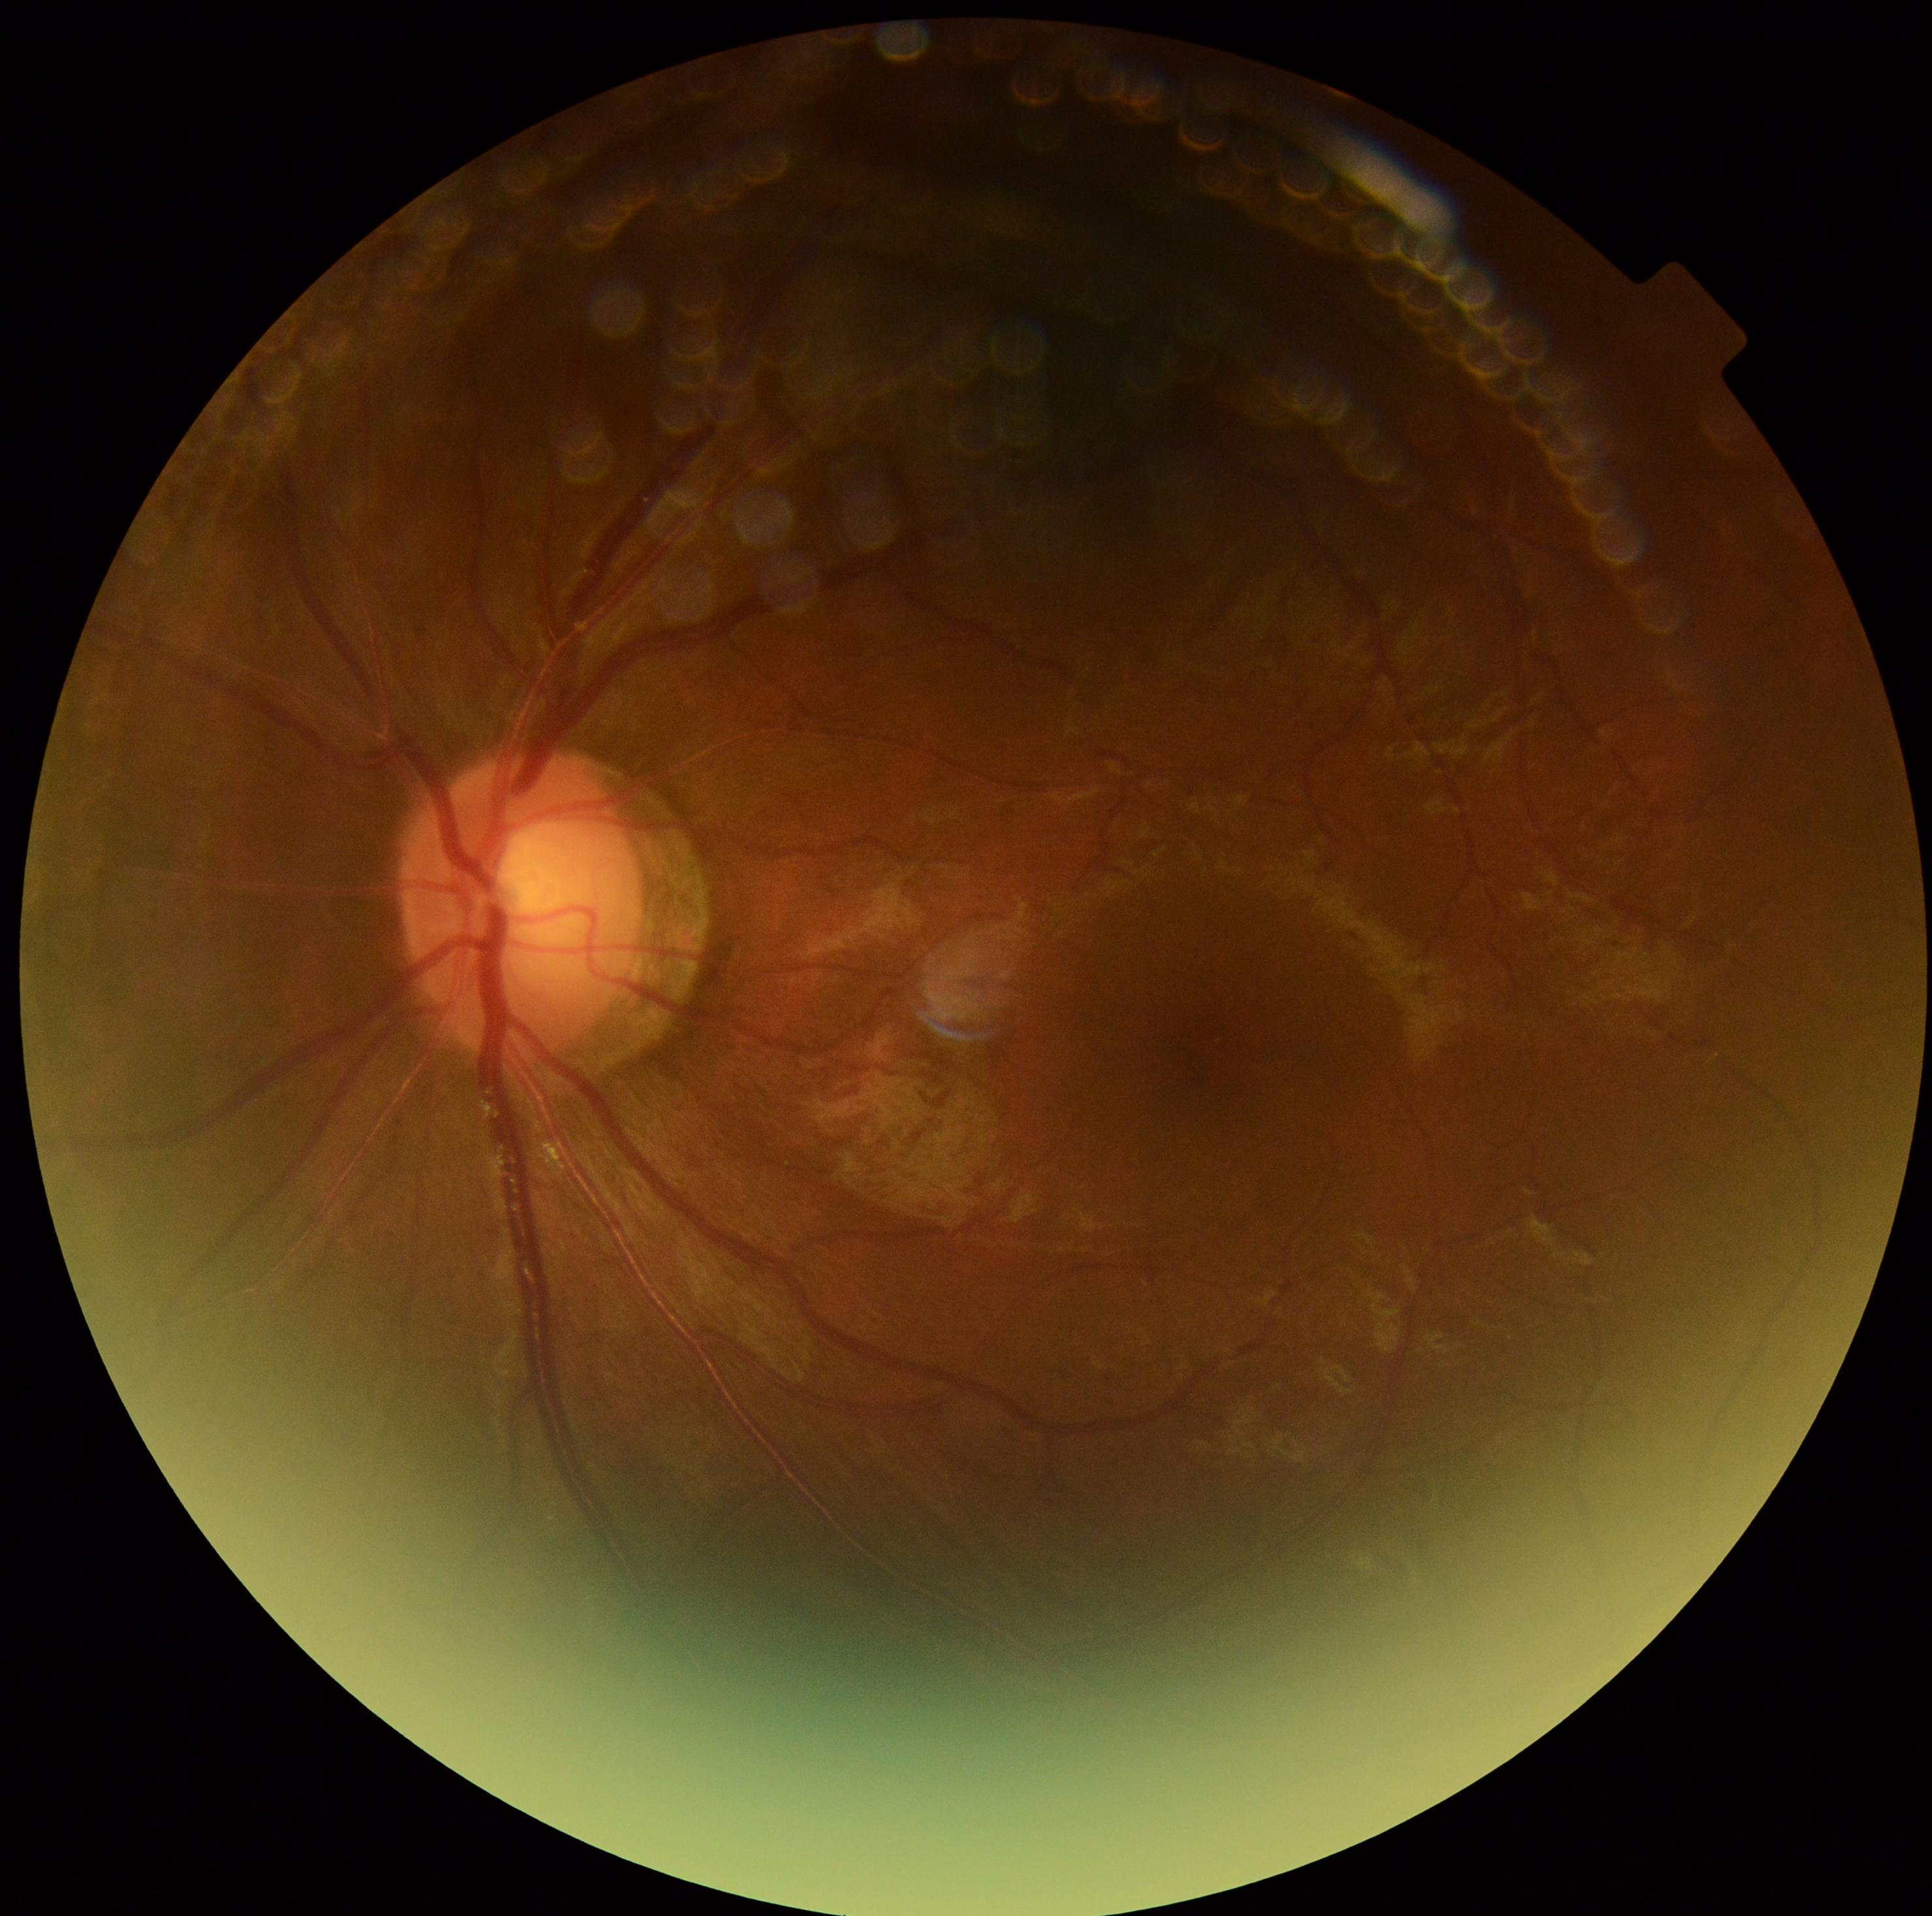 DR: 0/4.